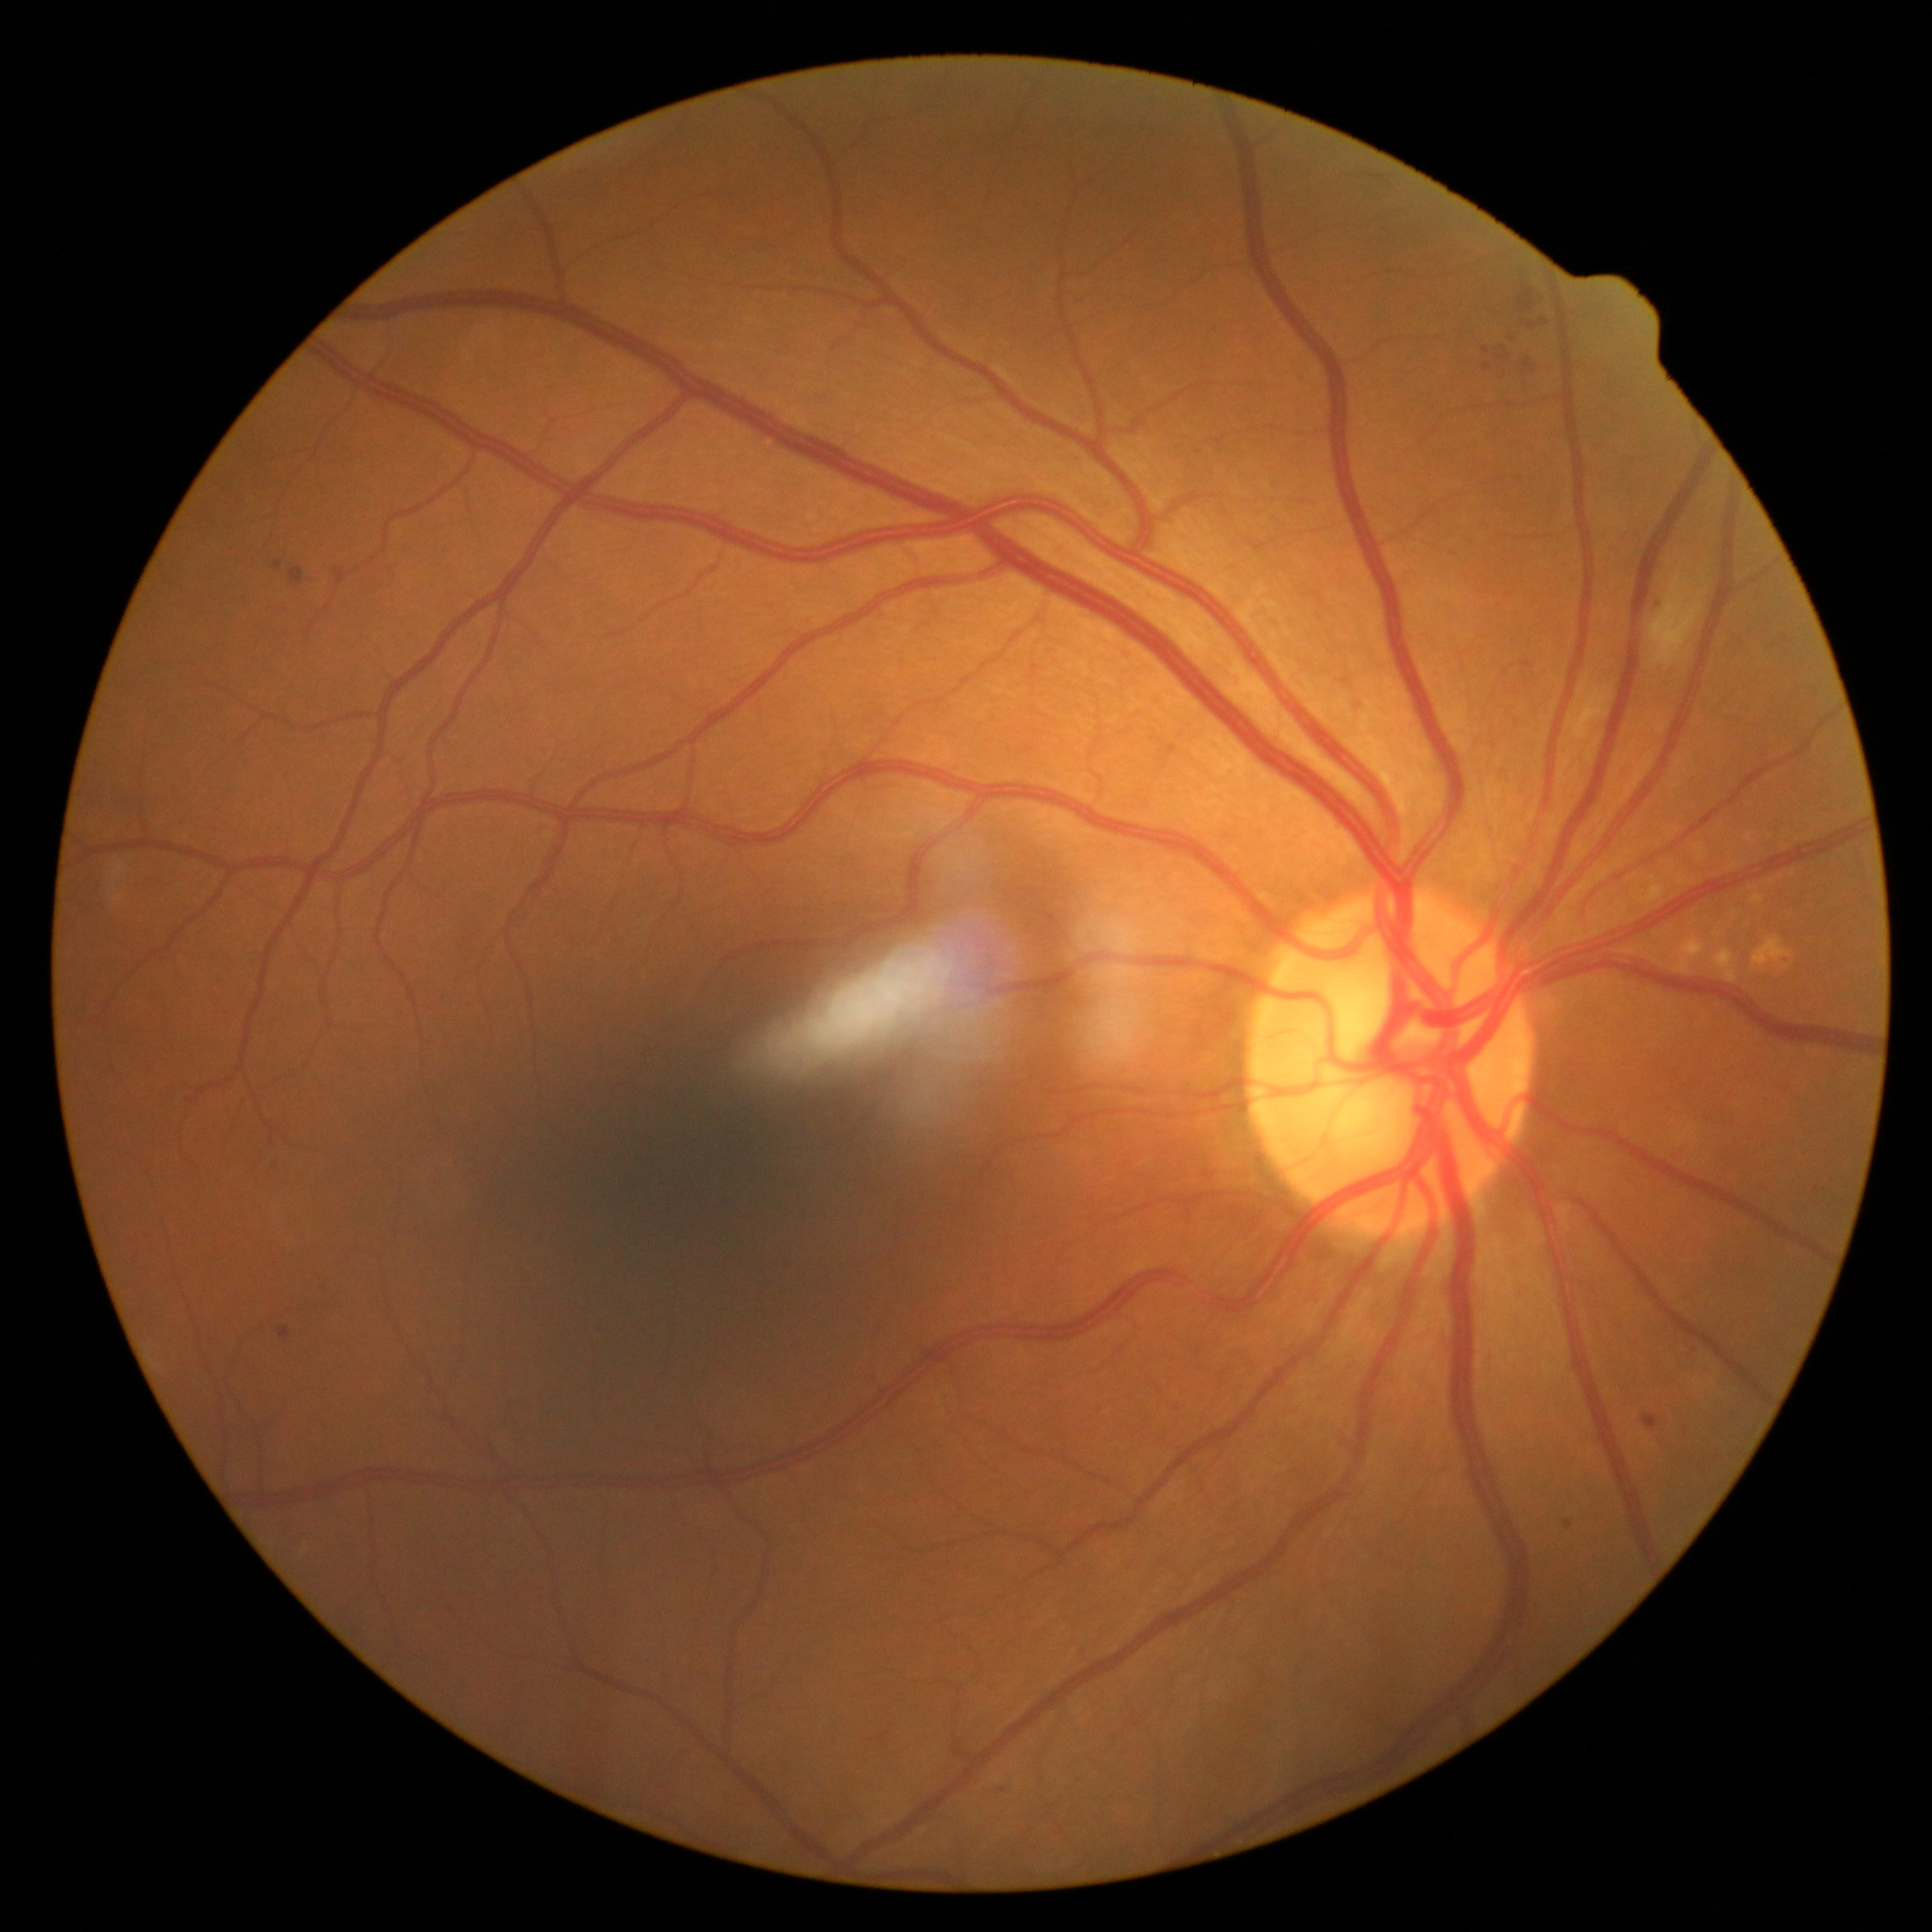

Diabetic retinopathy (DR) is 2/4. Hemorrhages (HEs) at [1519,290,1538,309] | [1519,353,1532,368]. Microaneurysms (MAs) at [1643,1415,1660,1429] | [1503,347,1510,359] | [279,1327,289,1339] | [1778,956,1787,965] | [289,569,304,584] | [1483,349,1491,355] | [1541,318,1548,326] | [273,561,282,570] | [1565,1519,1574,1528] | [336,569,347,584]. Additional small MAs near <pt>1689,1349</pt> | <pt>1002,1790</pt> | <pt>1488,368</pt> | <pt>274,1165</pt> | <pt>1532,326</pt>. No hard exudates (EXs) identified. Soft exudates (SEs) at [1647,569,1704,667].